Color fundus photograph · 1932 x 1910 pixels: 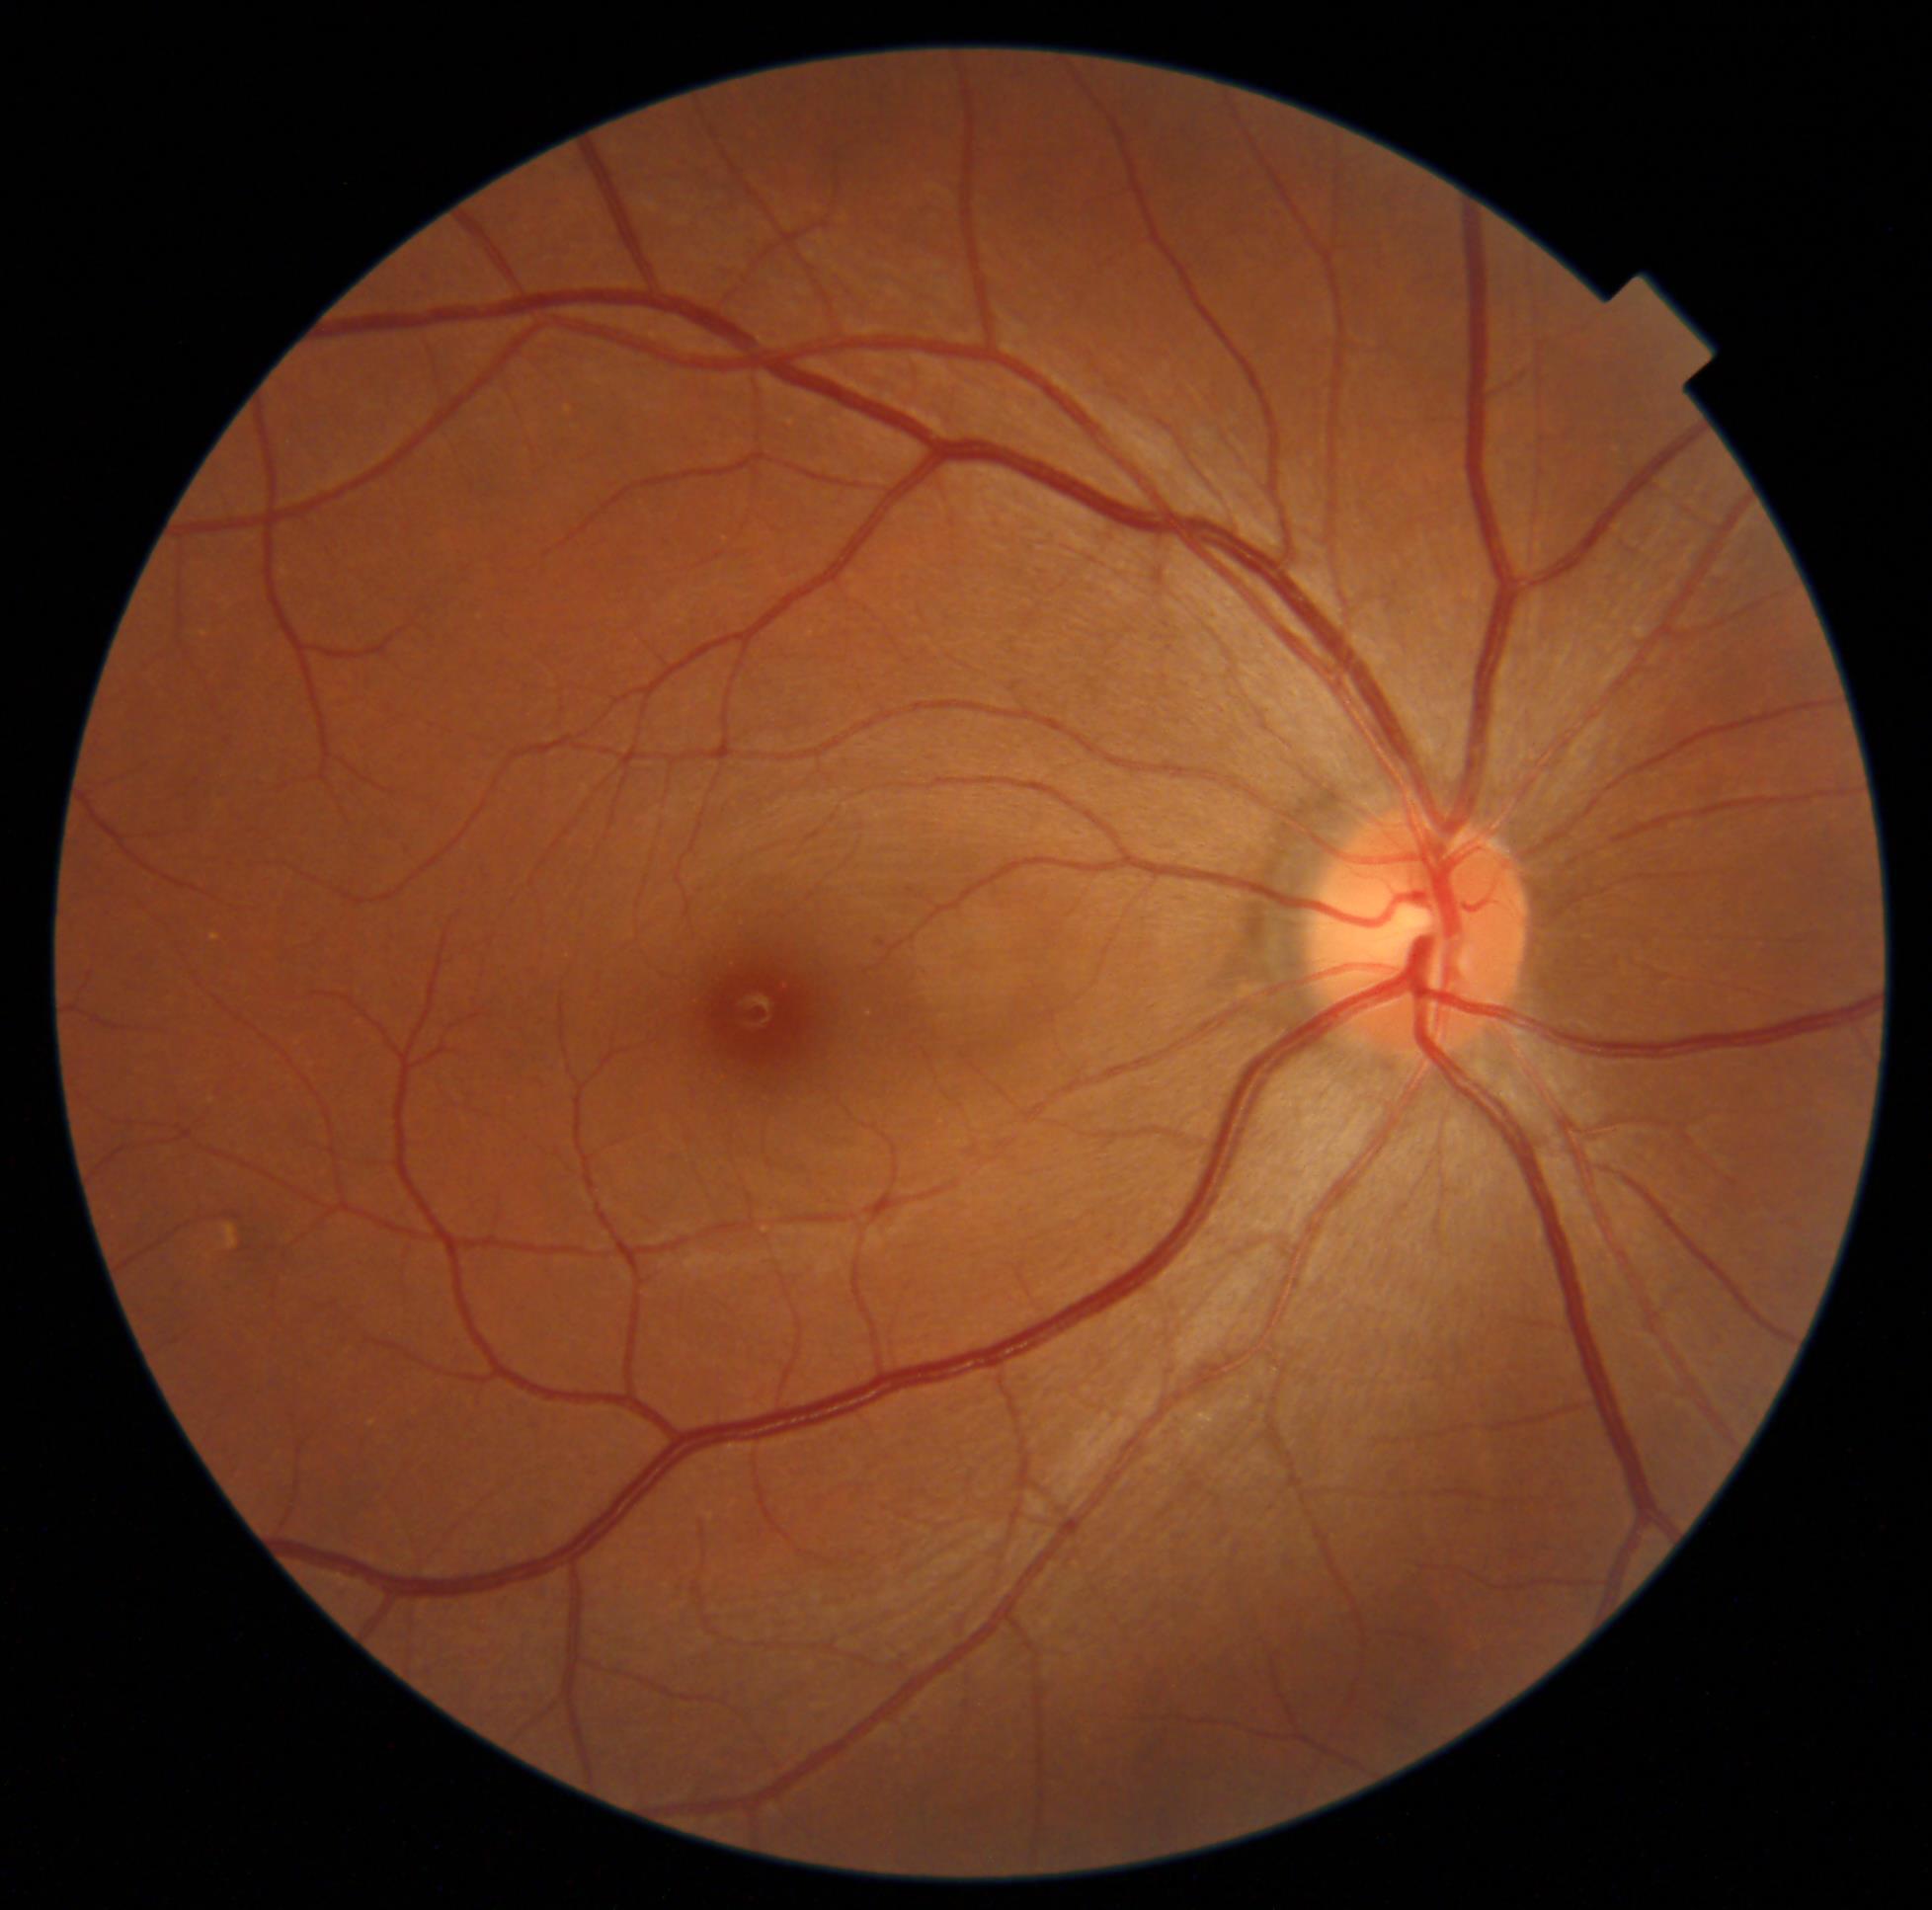
diabetic retinopathy (DR): 1/4
DR class: non-proliferative diabetic retinopathy